Color fundus image · 45° FOV · 2048x1536.
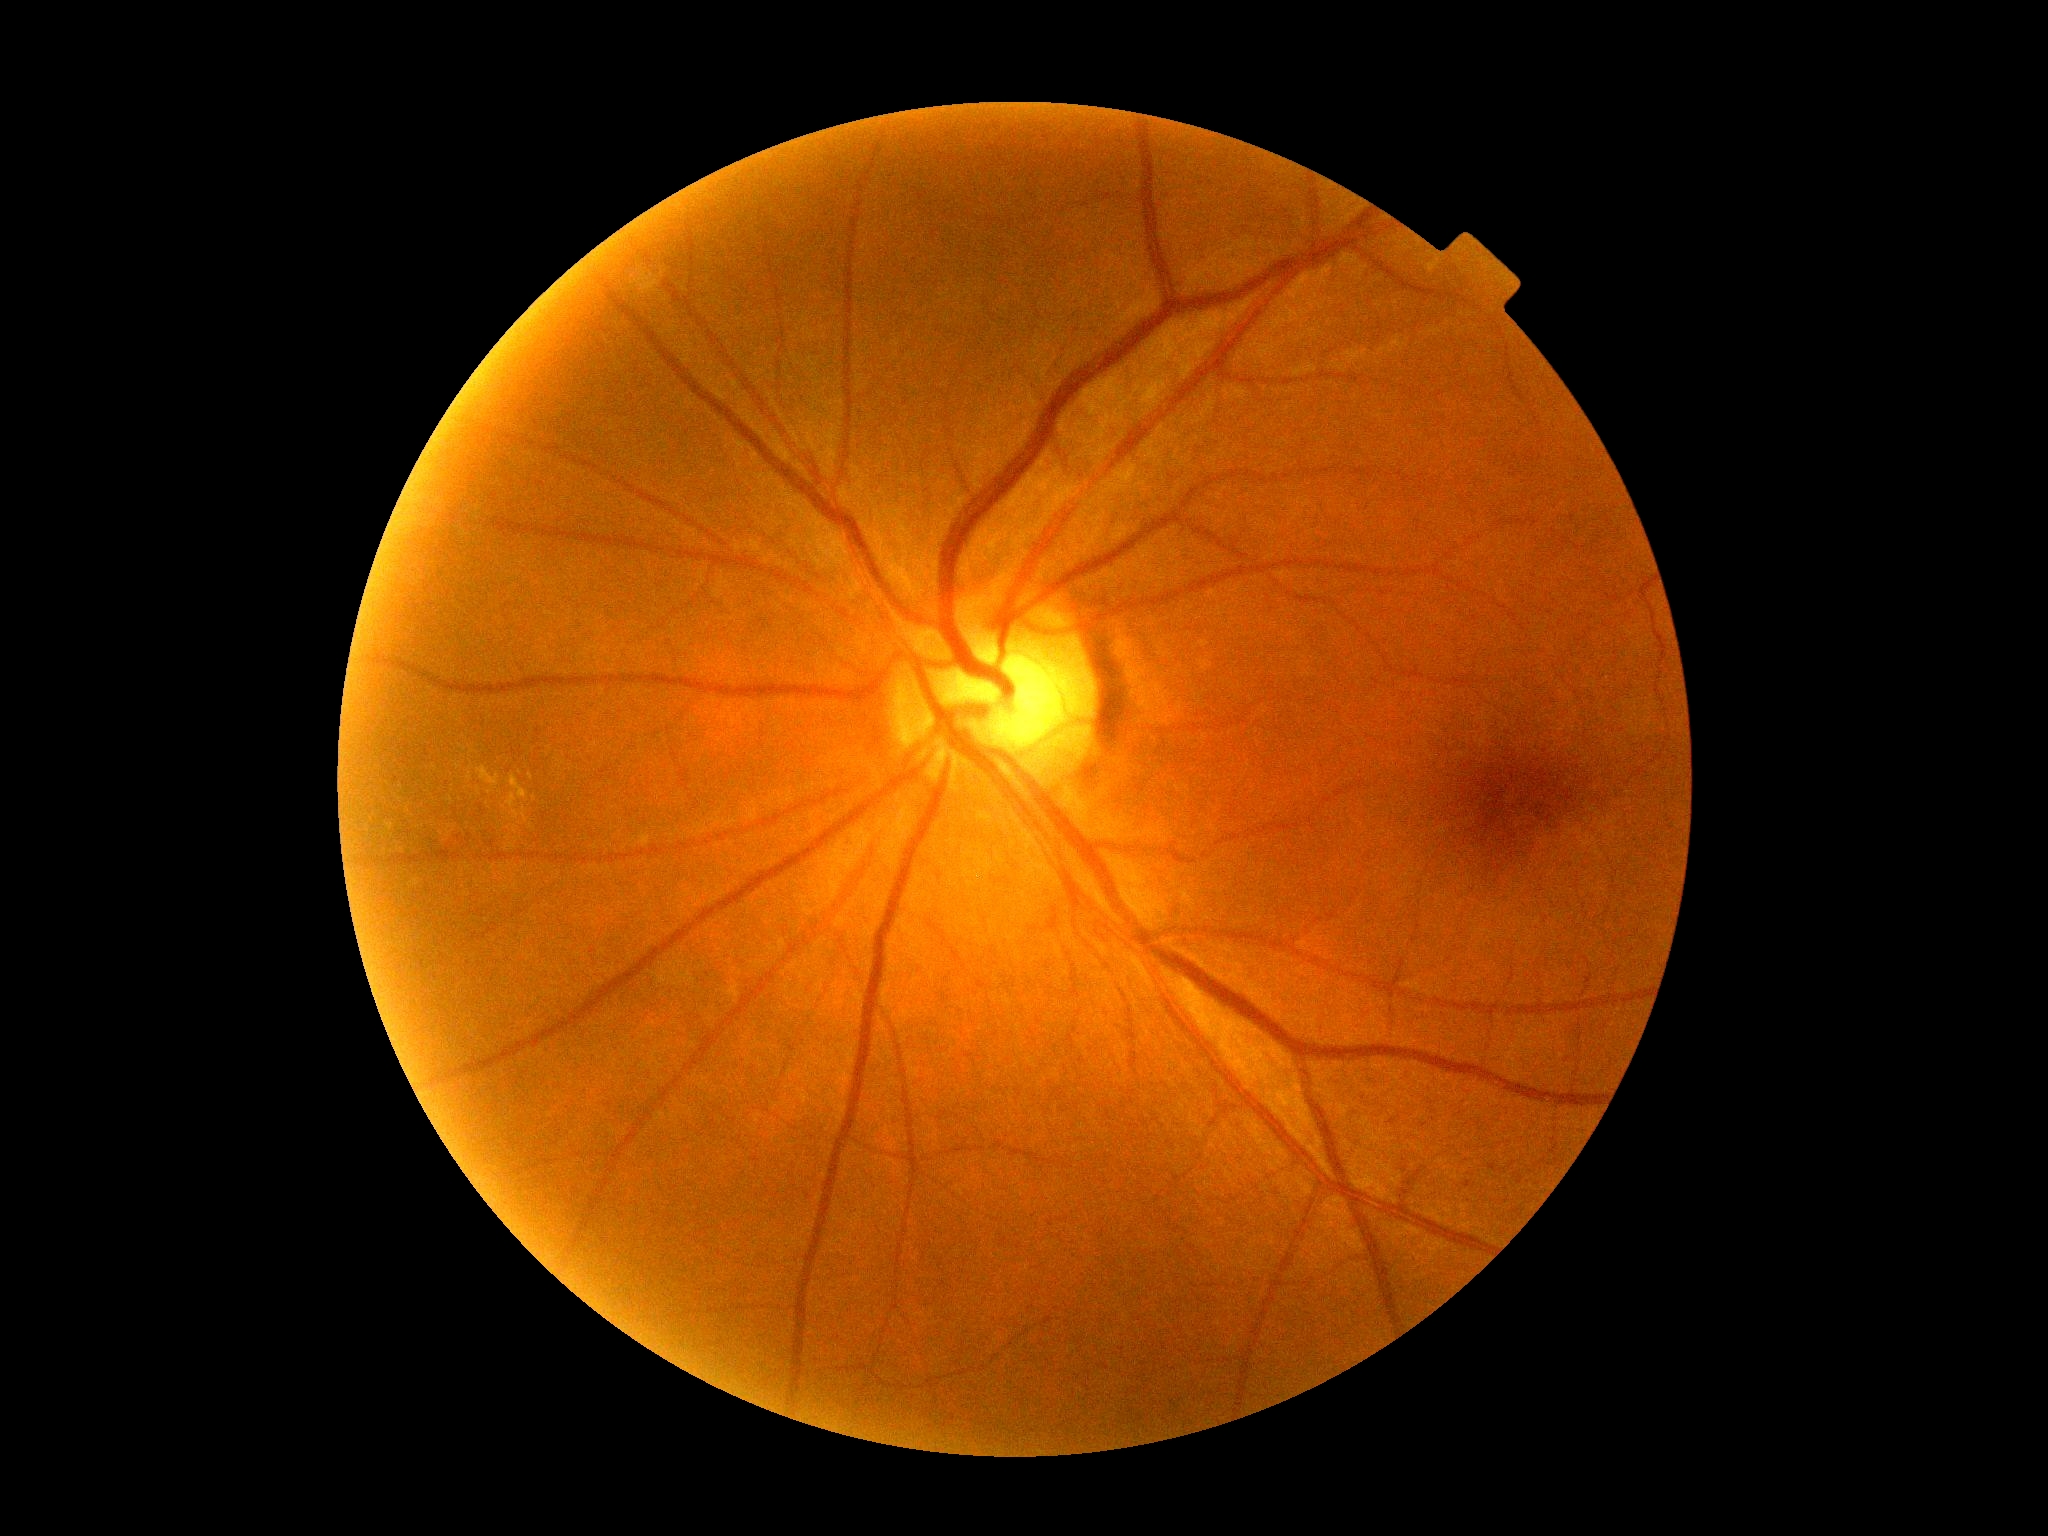
Disease class: non-proliferative diabetic retinopathy.
DR grade: 2/4.